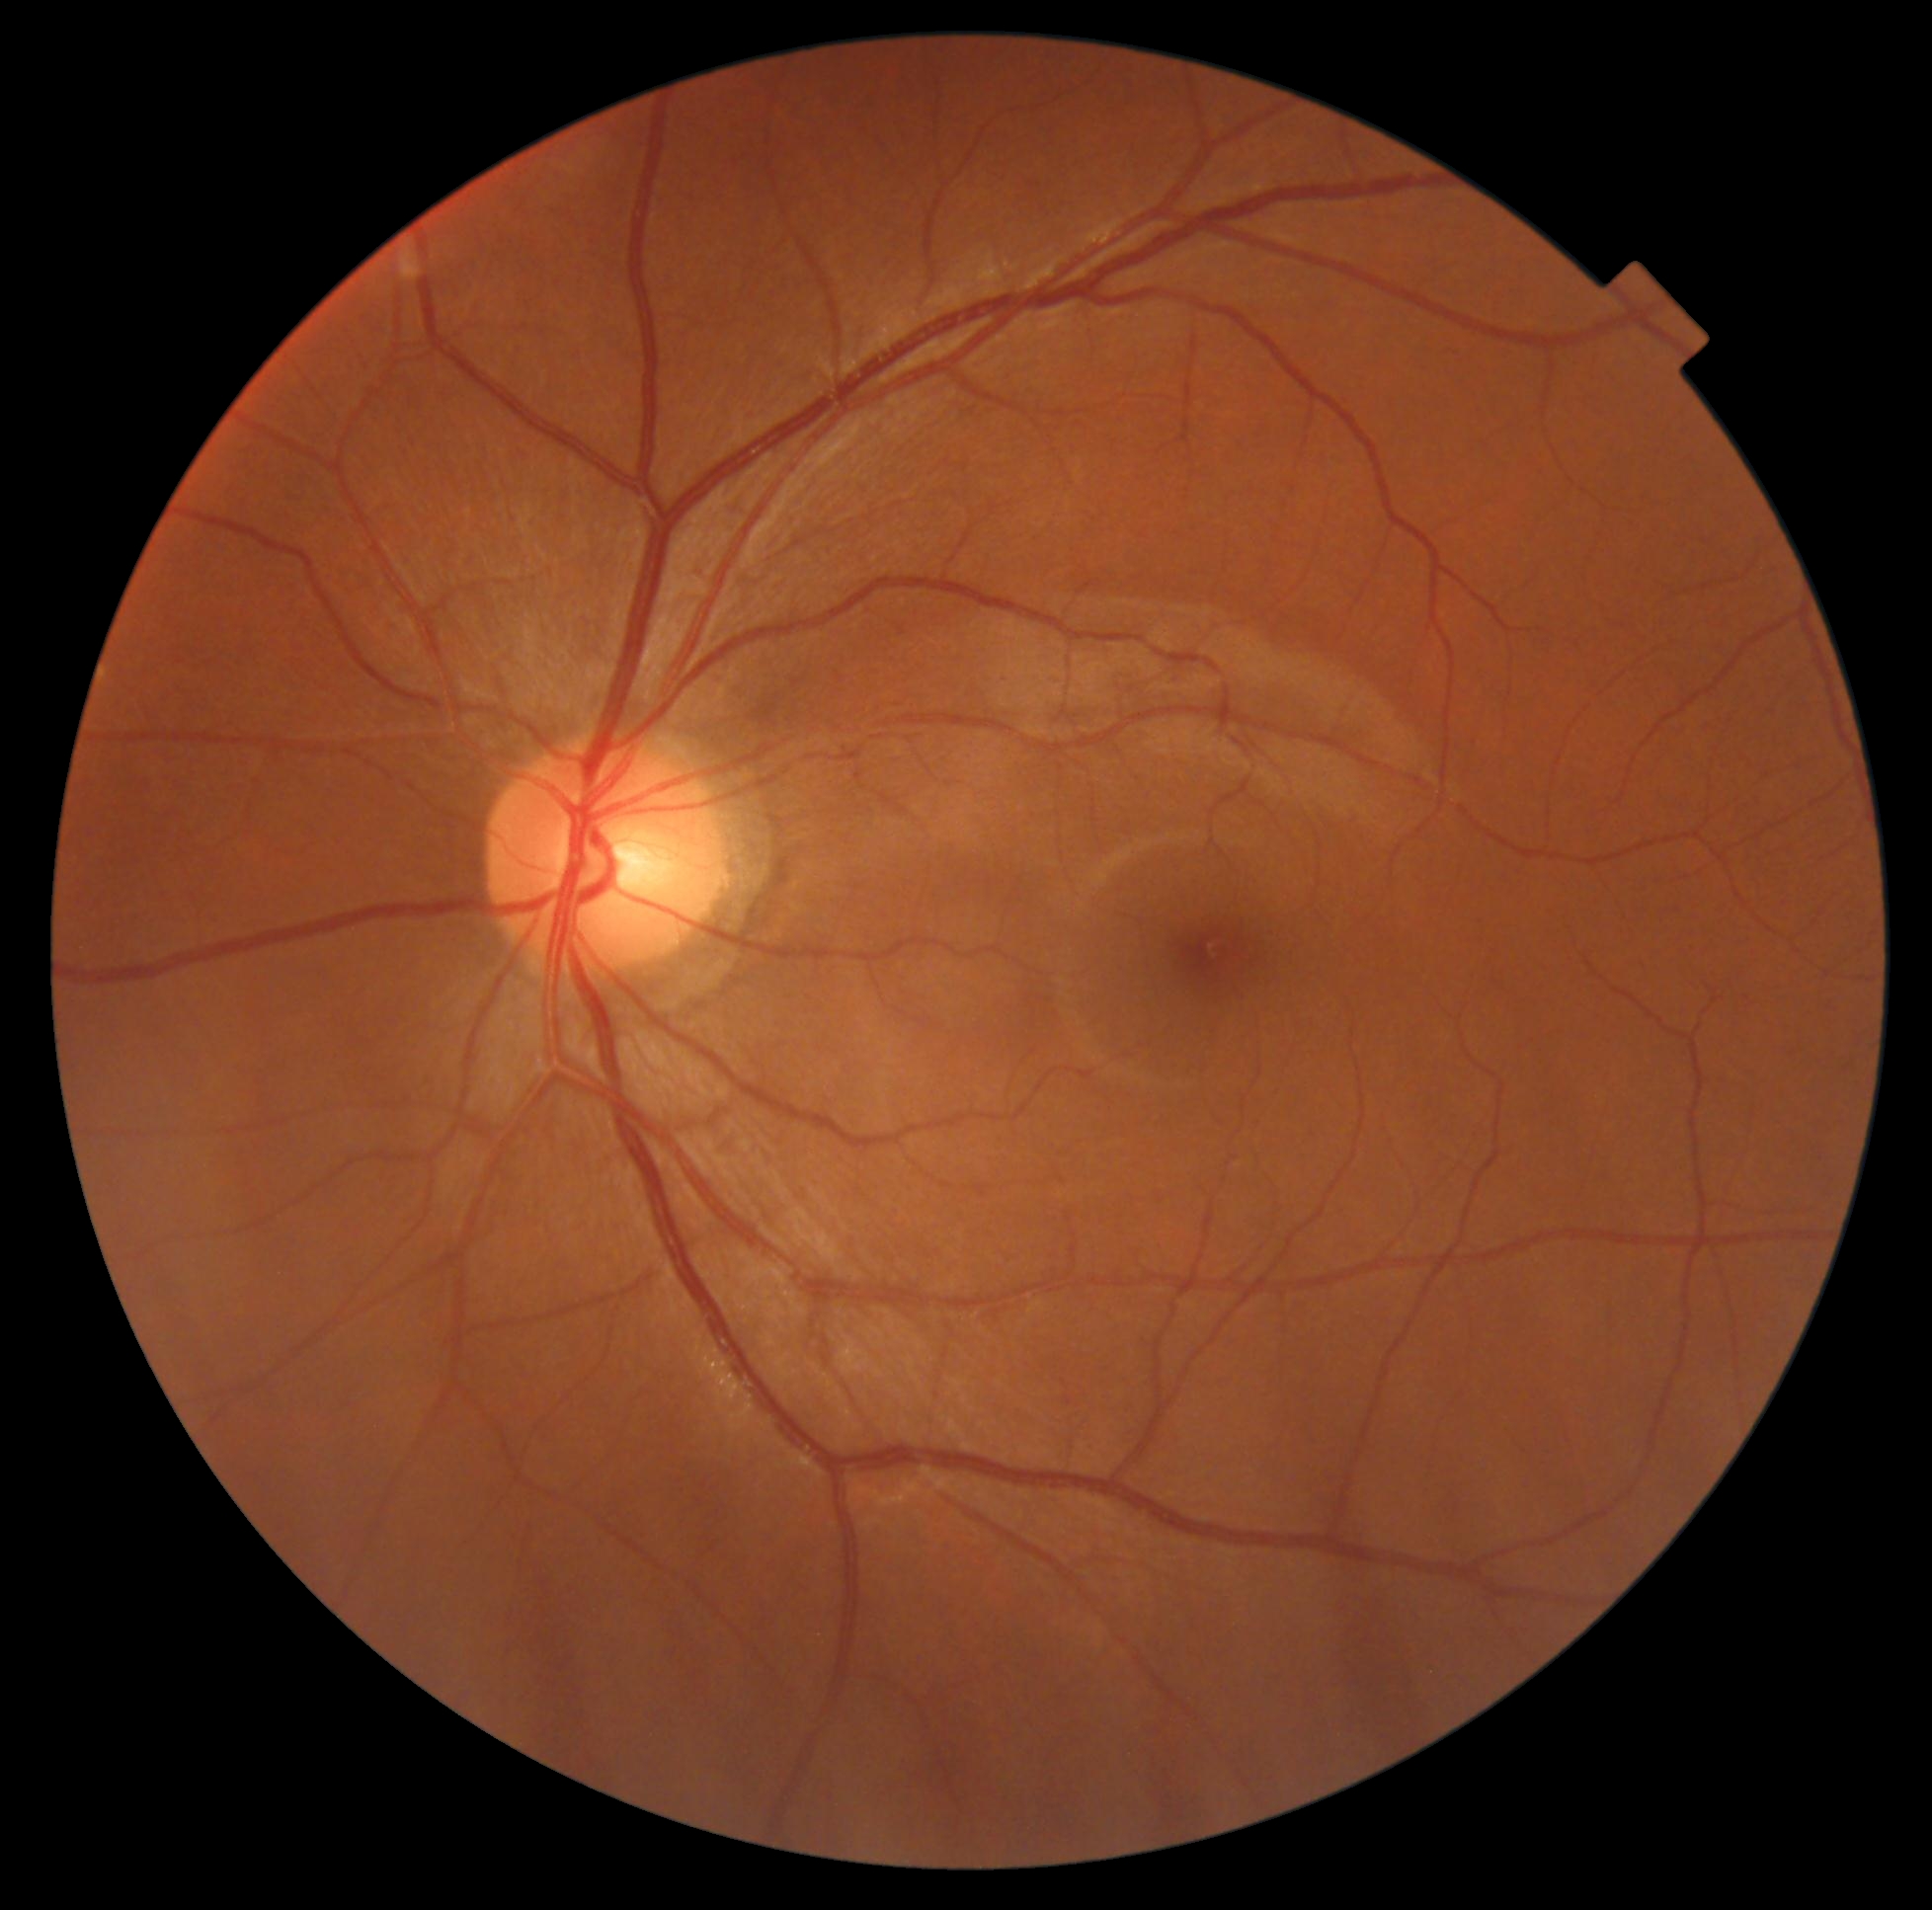

DR is grade 0.